Corneal thickness: 526 µm · woman · age 81.
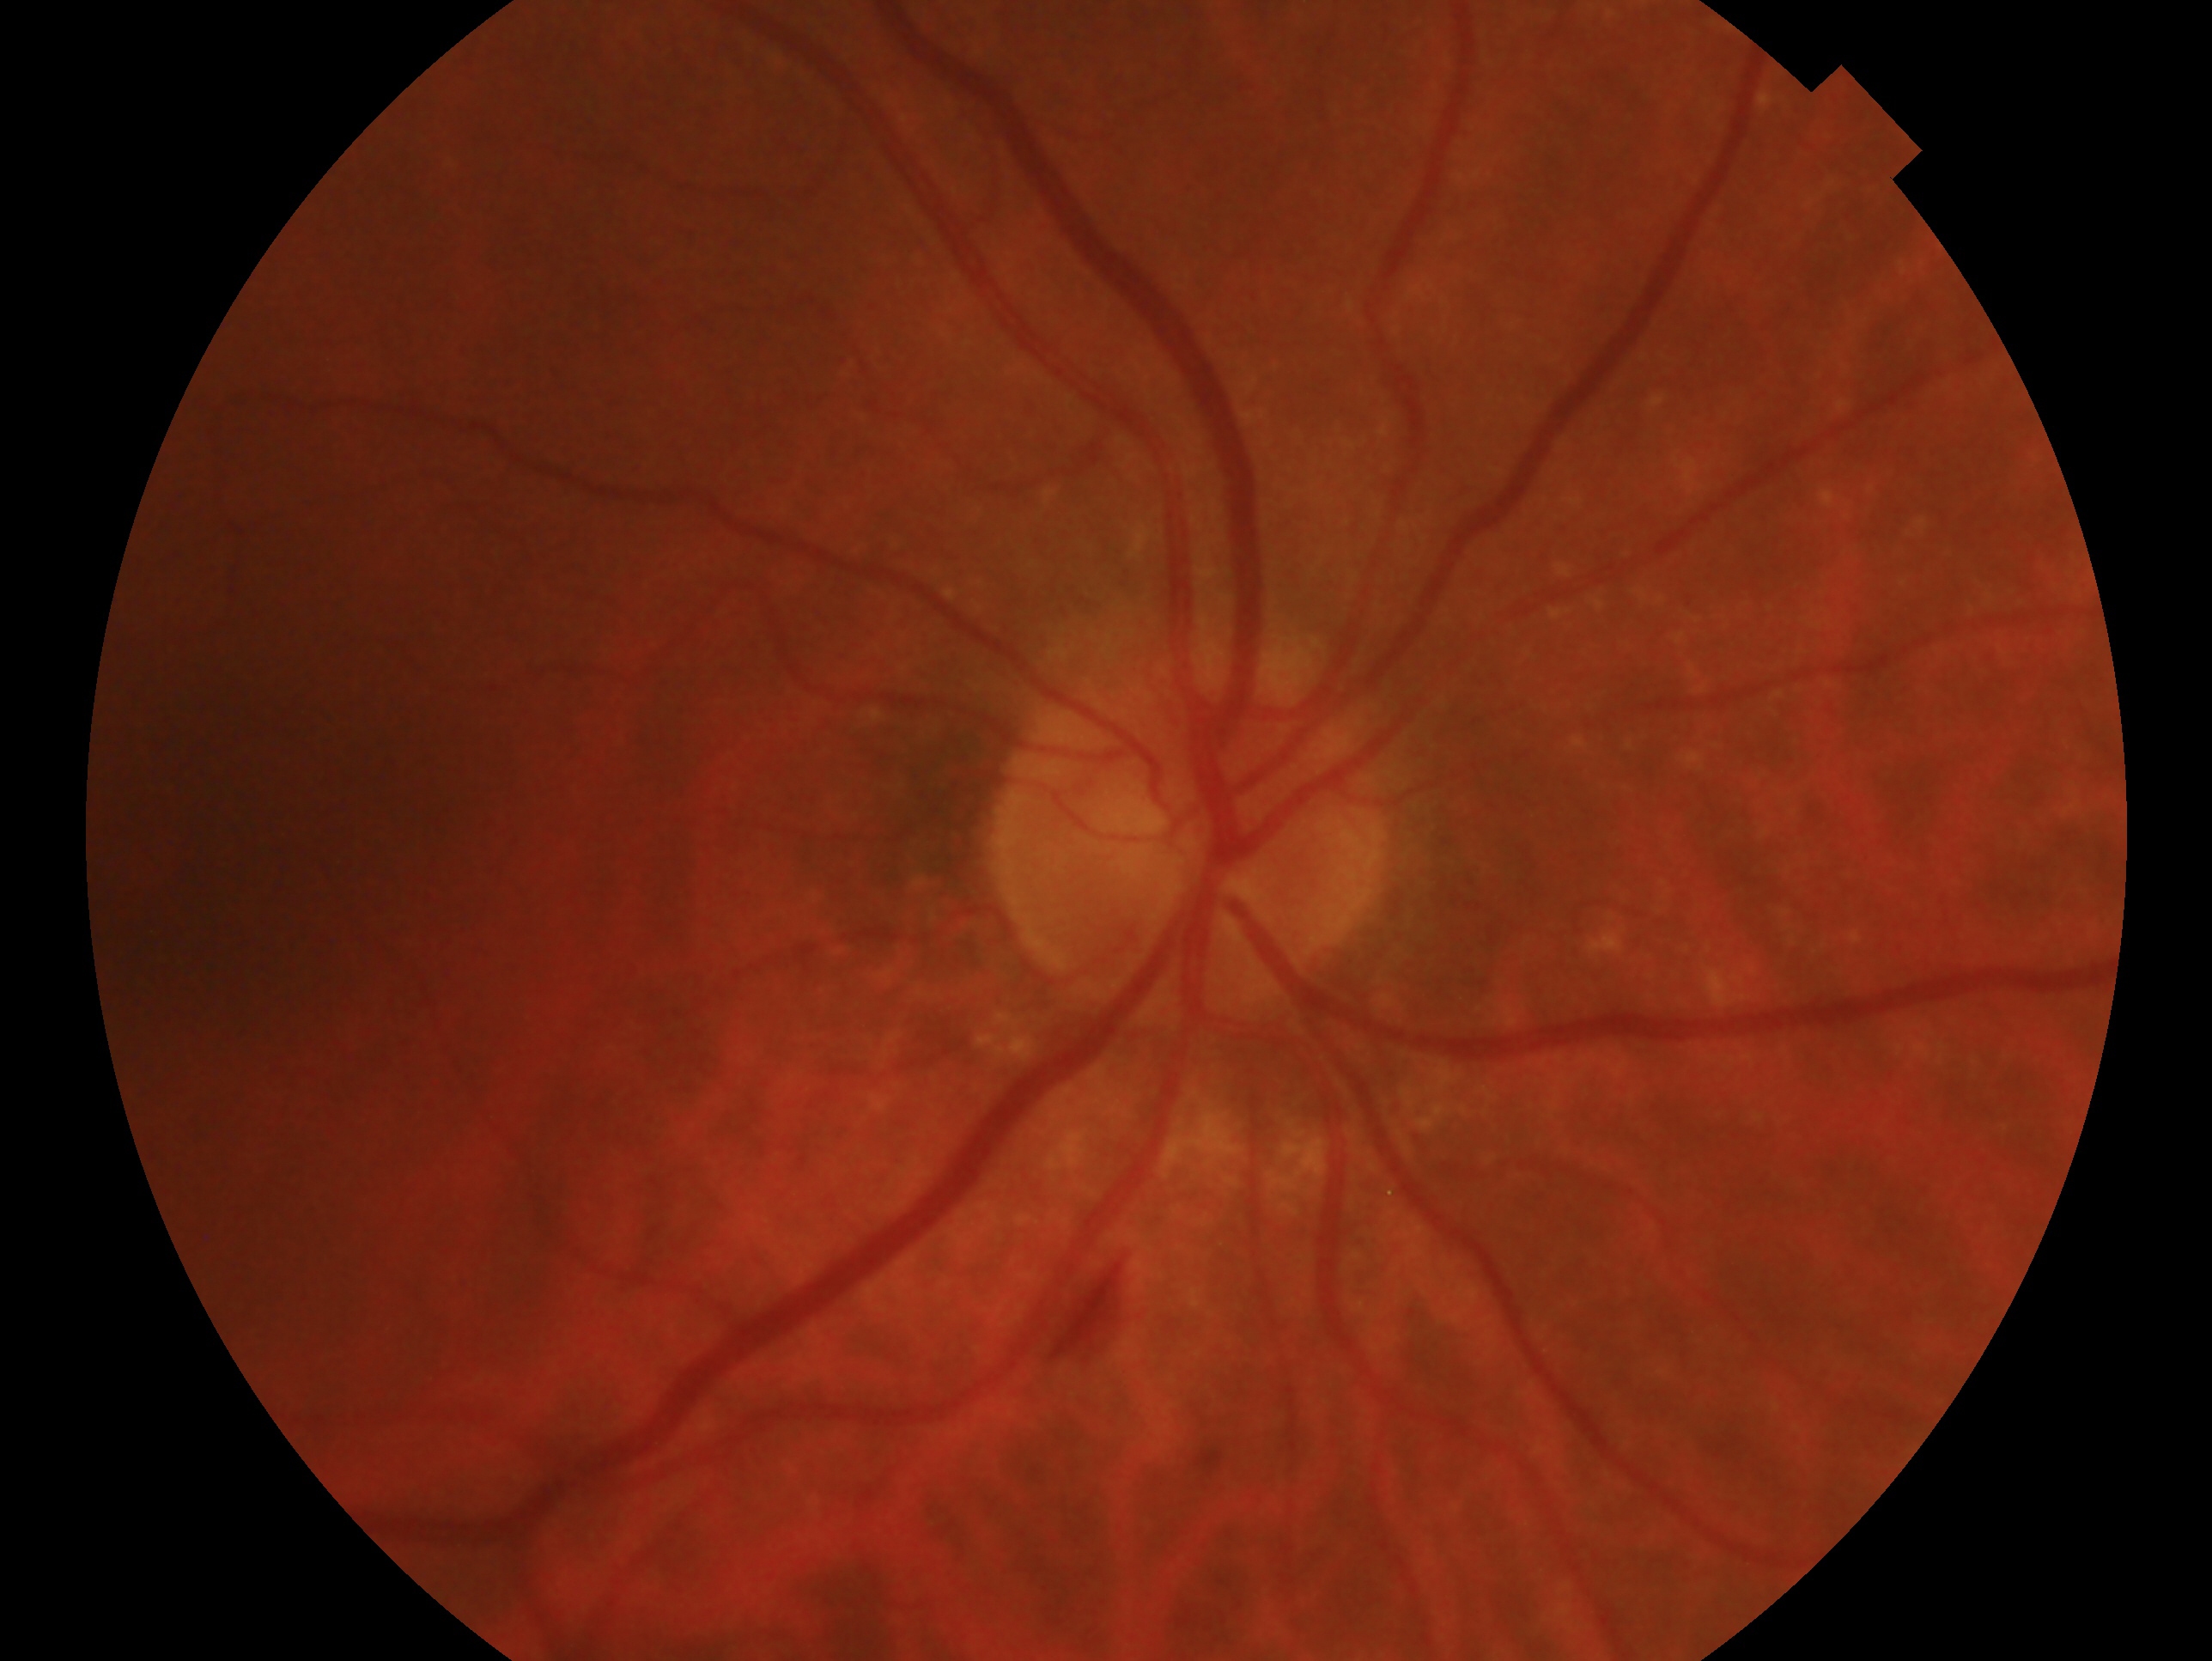
Findings:
– eye — OD
– glaucoma status — no glaucomatous findings